Pediatric retinal photograph (wide-field); acquired on the Phoenix ICON:
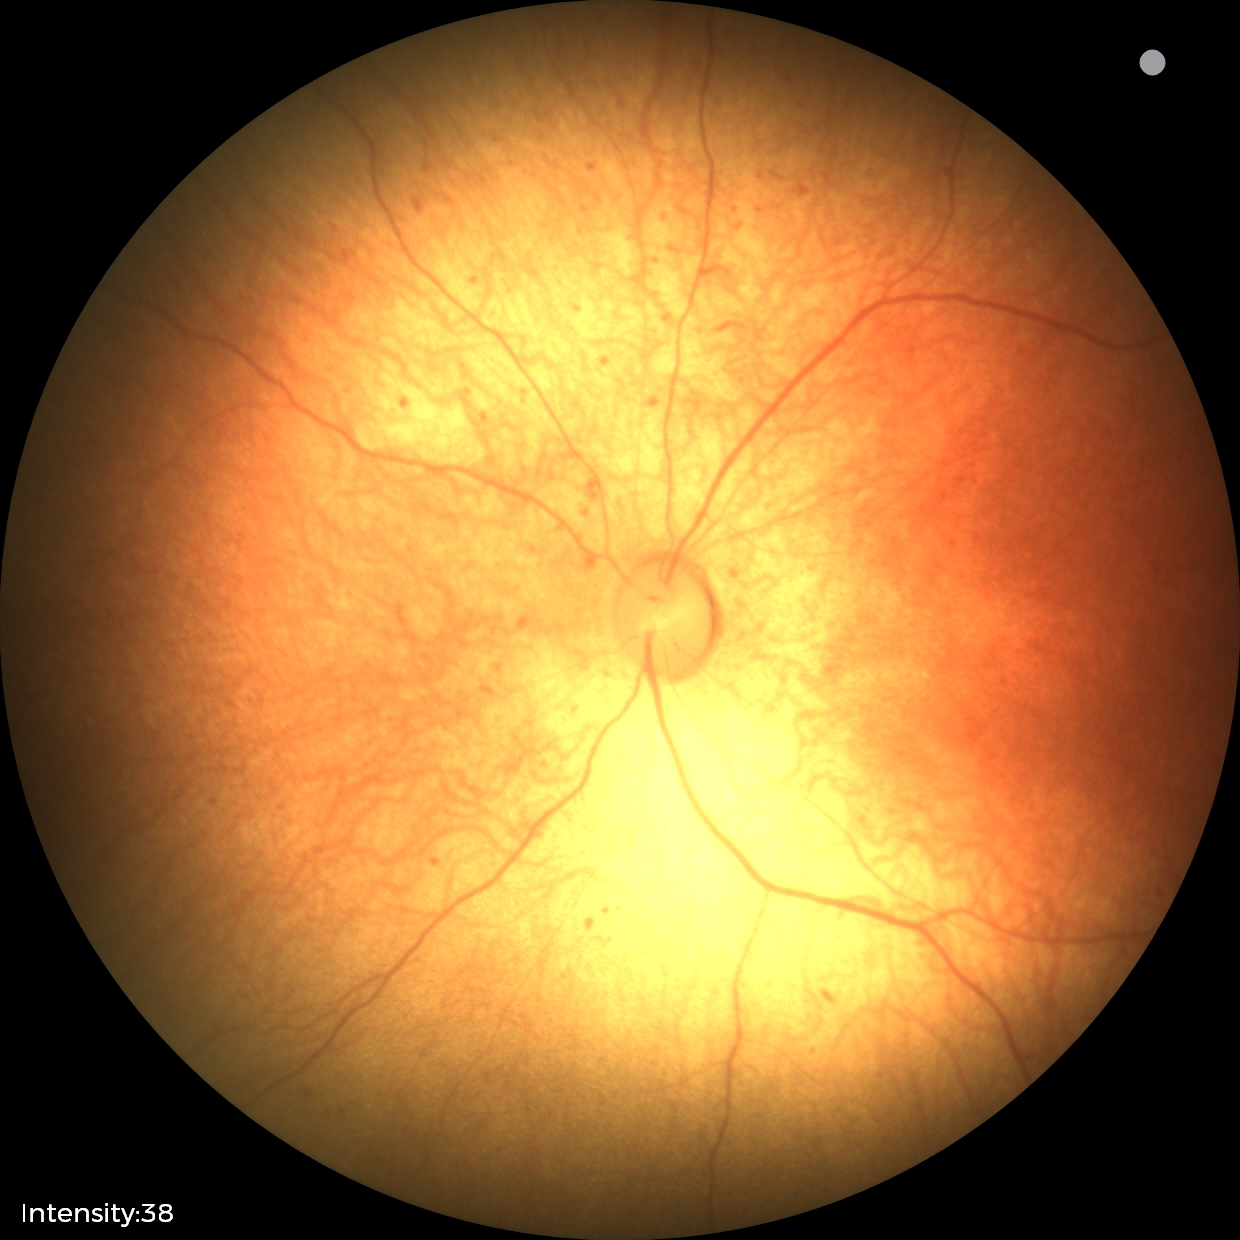 No plus disease. Series diagnosed as status post retinopathy of prematurity (ROP).